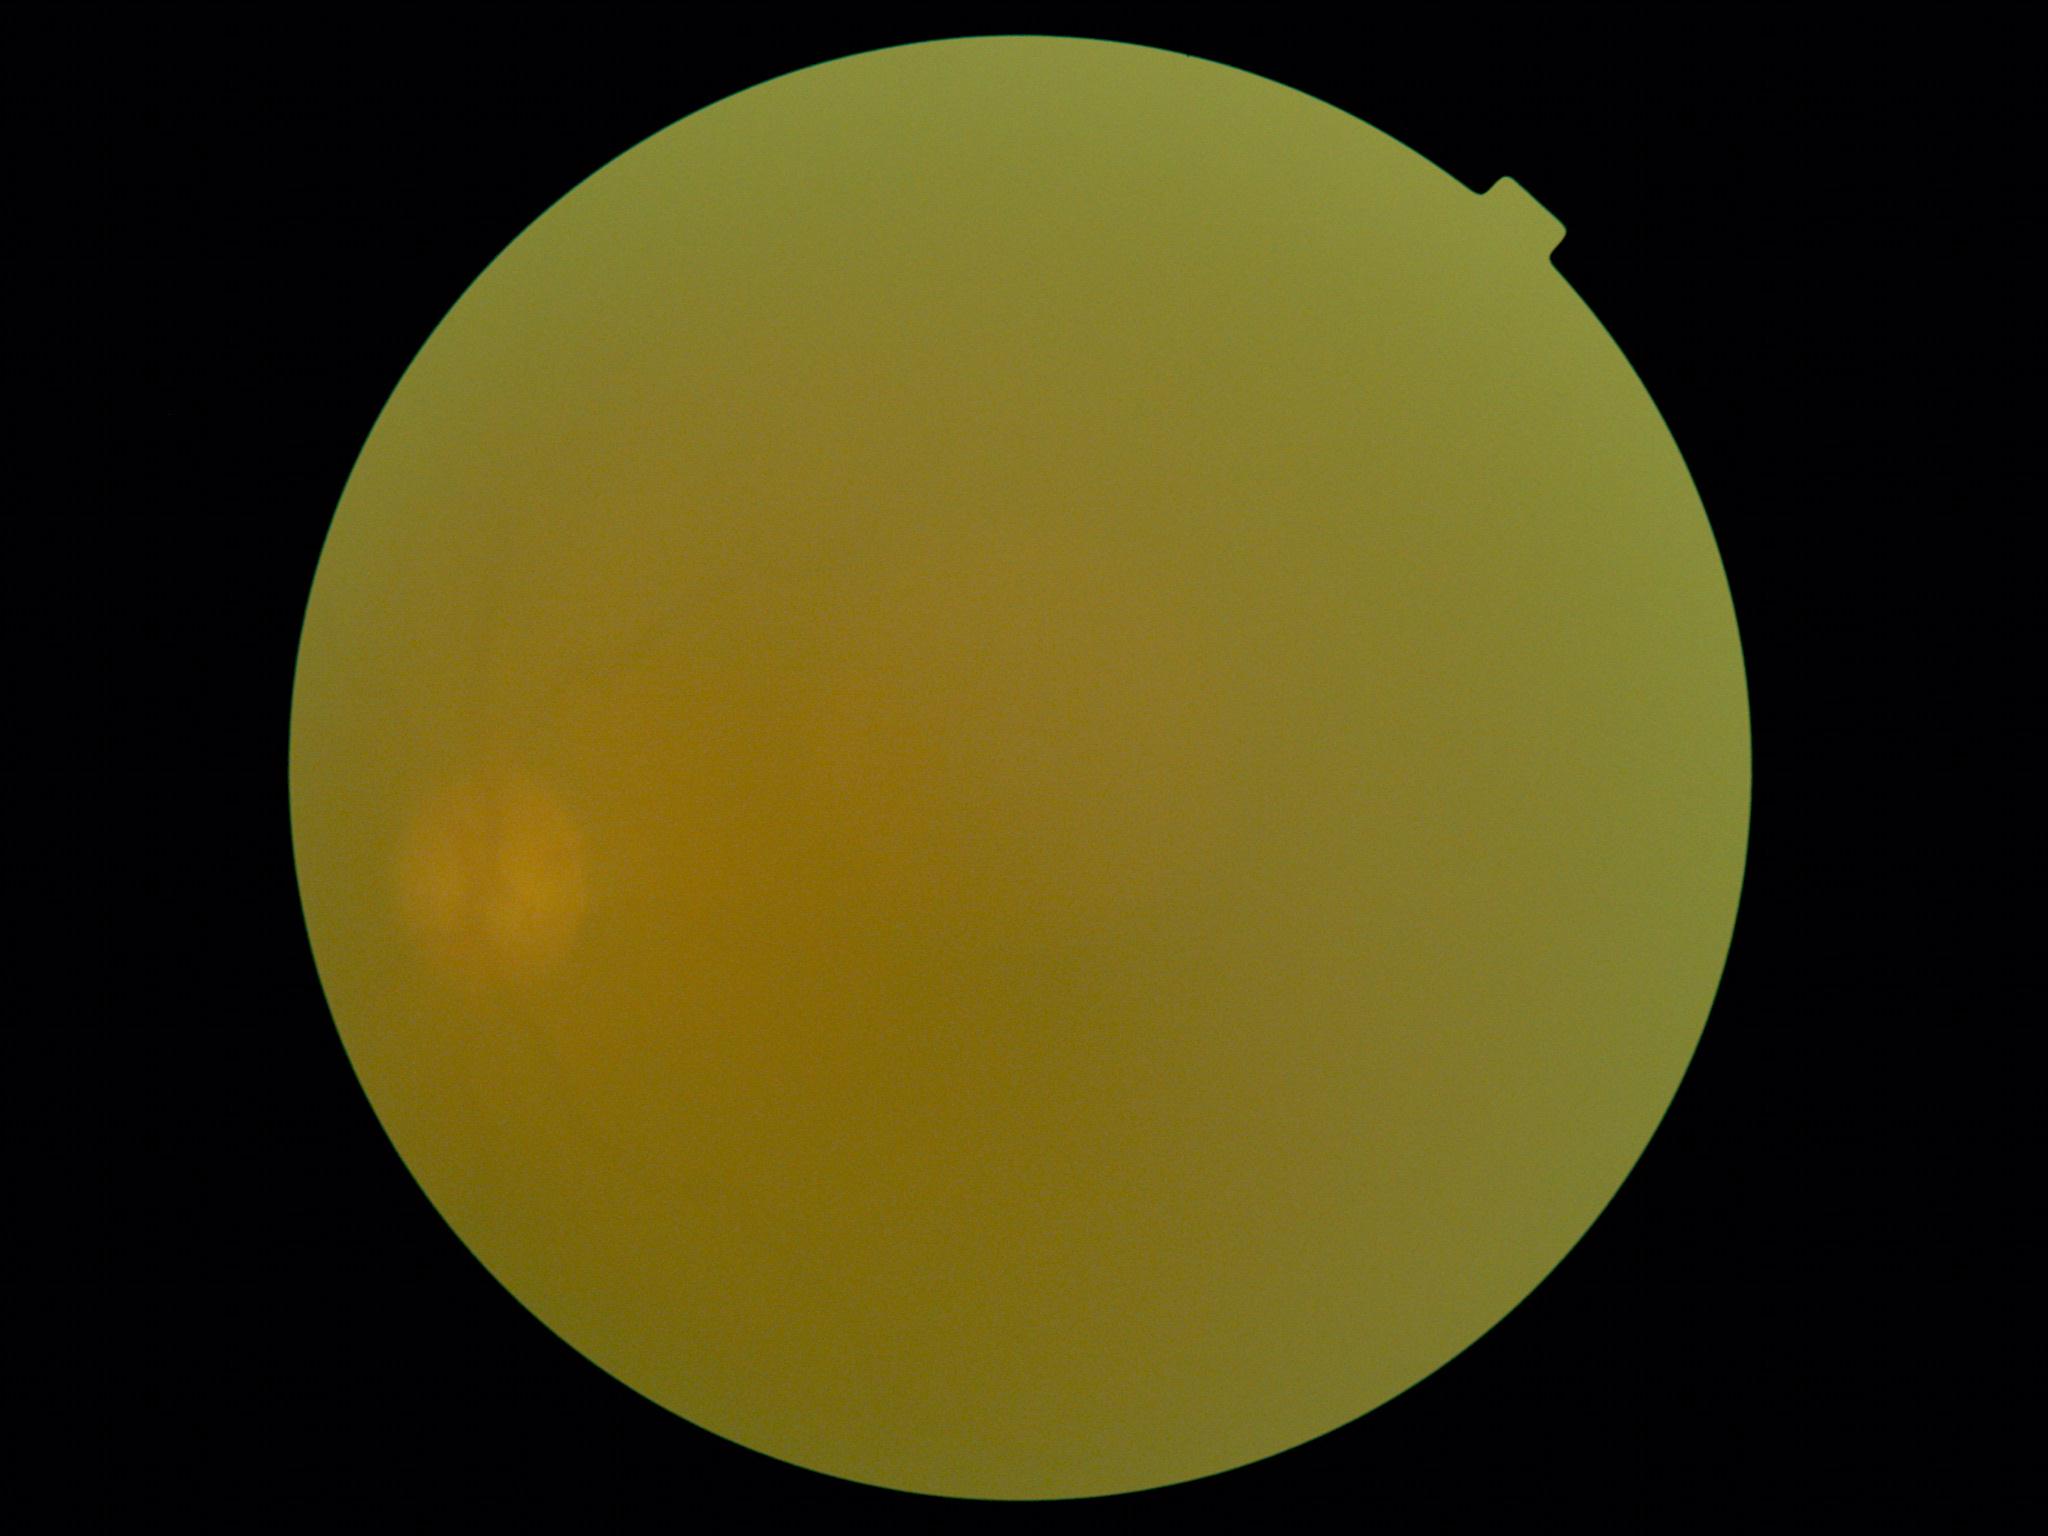 Ungradable image — DR severity cannot be determined. Diabetic retinopathy is ungradable.